Fundus photo, DR severity per modified Davis staging: 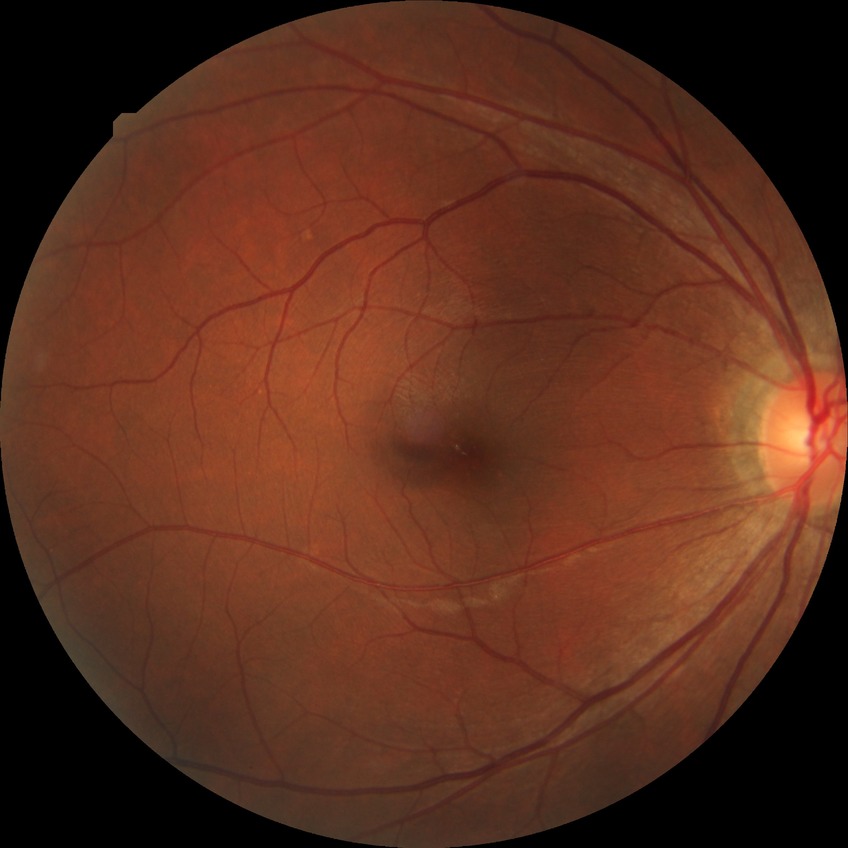
modified Davis grading: simple diabetic retinopathy.